2352x1568px · retinal fundus photograph · 45° FOV: 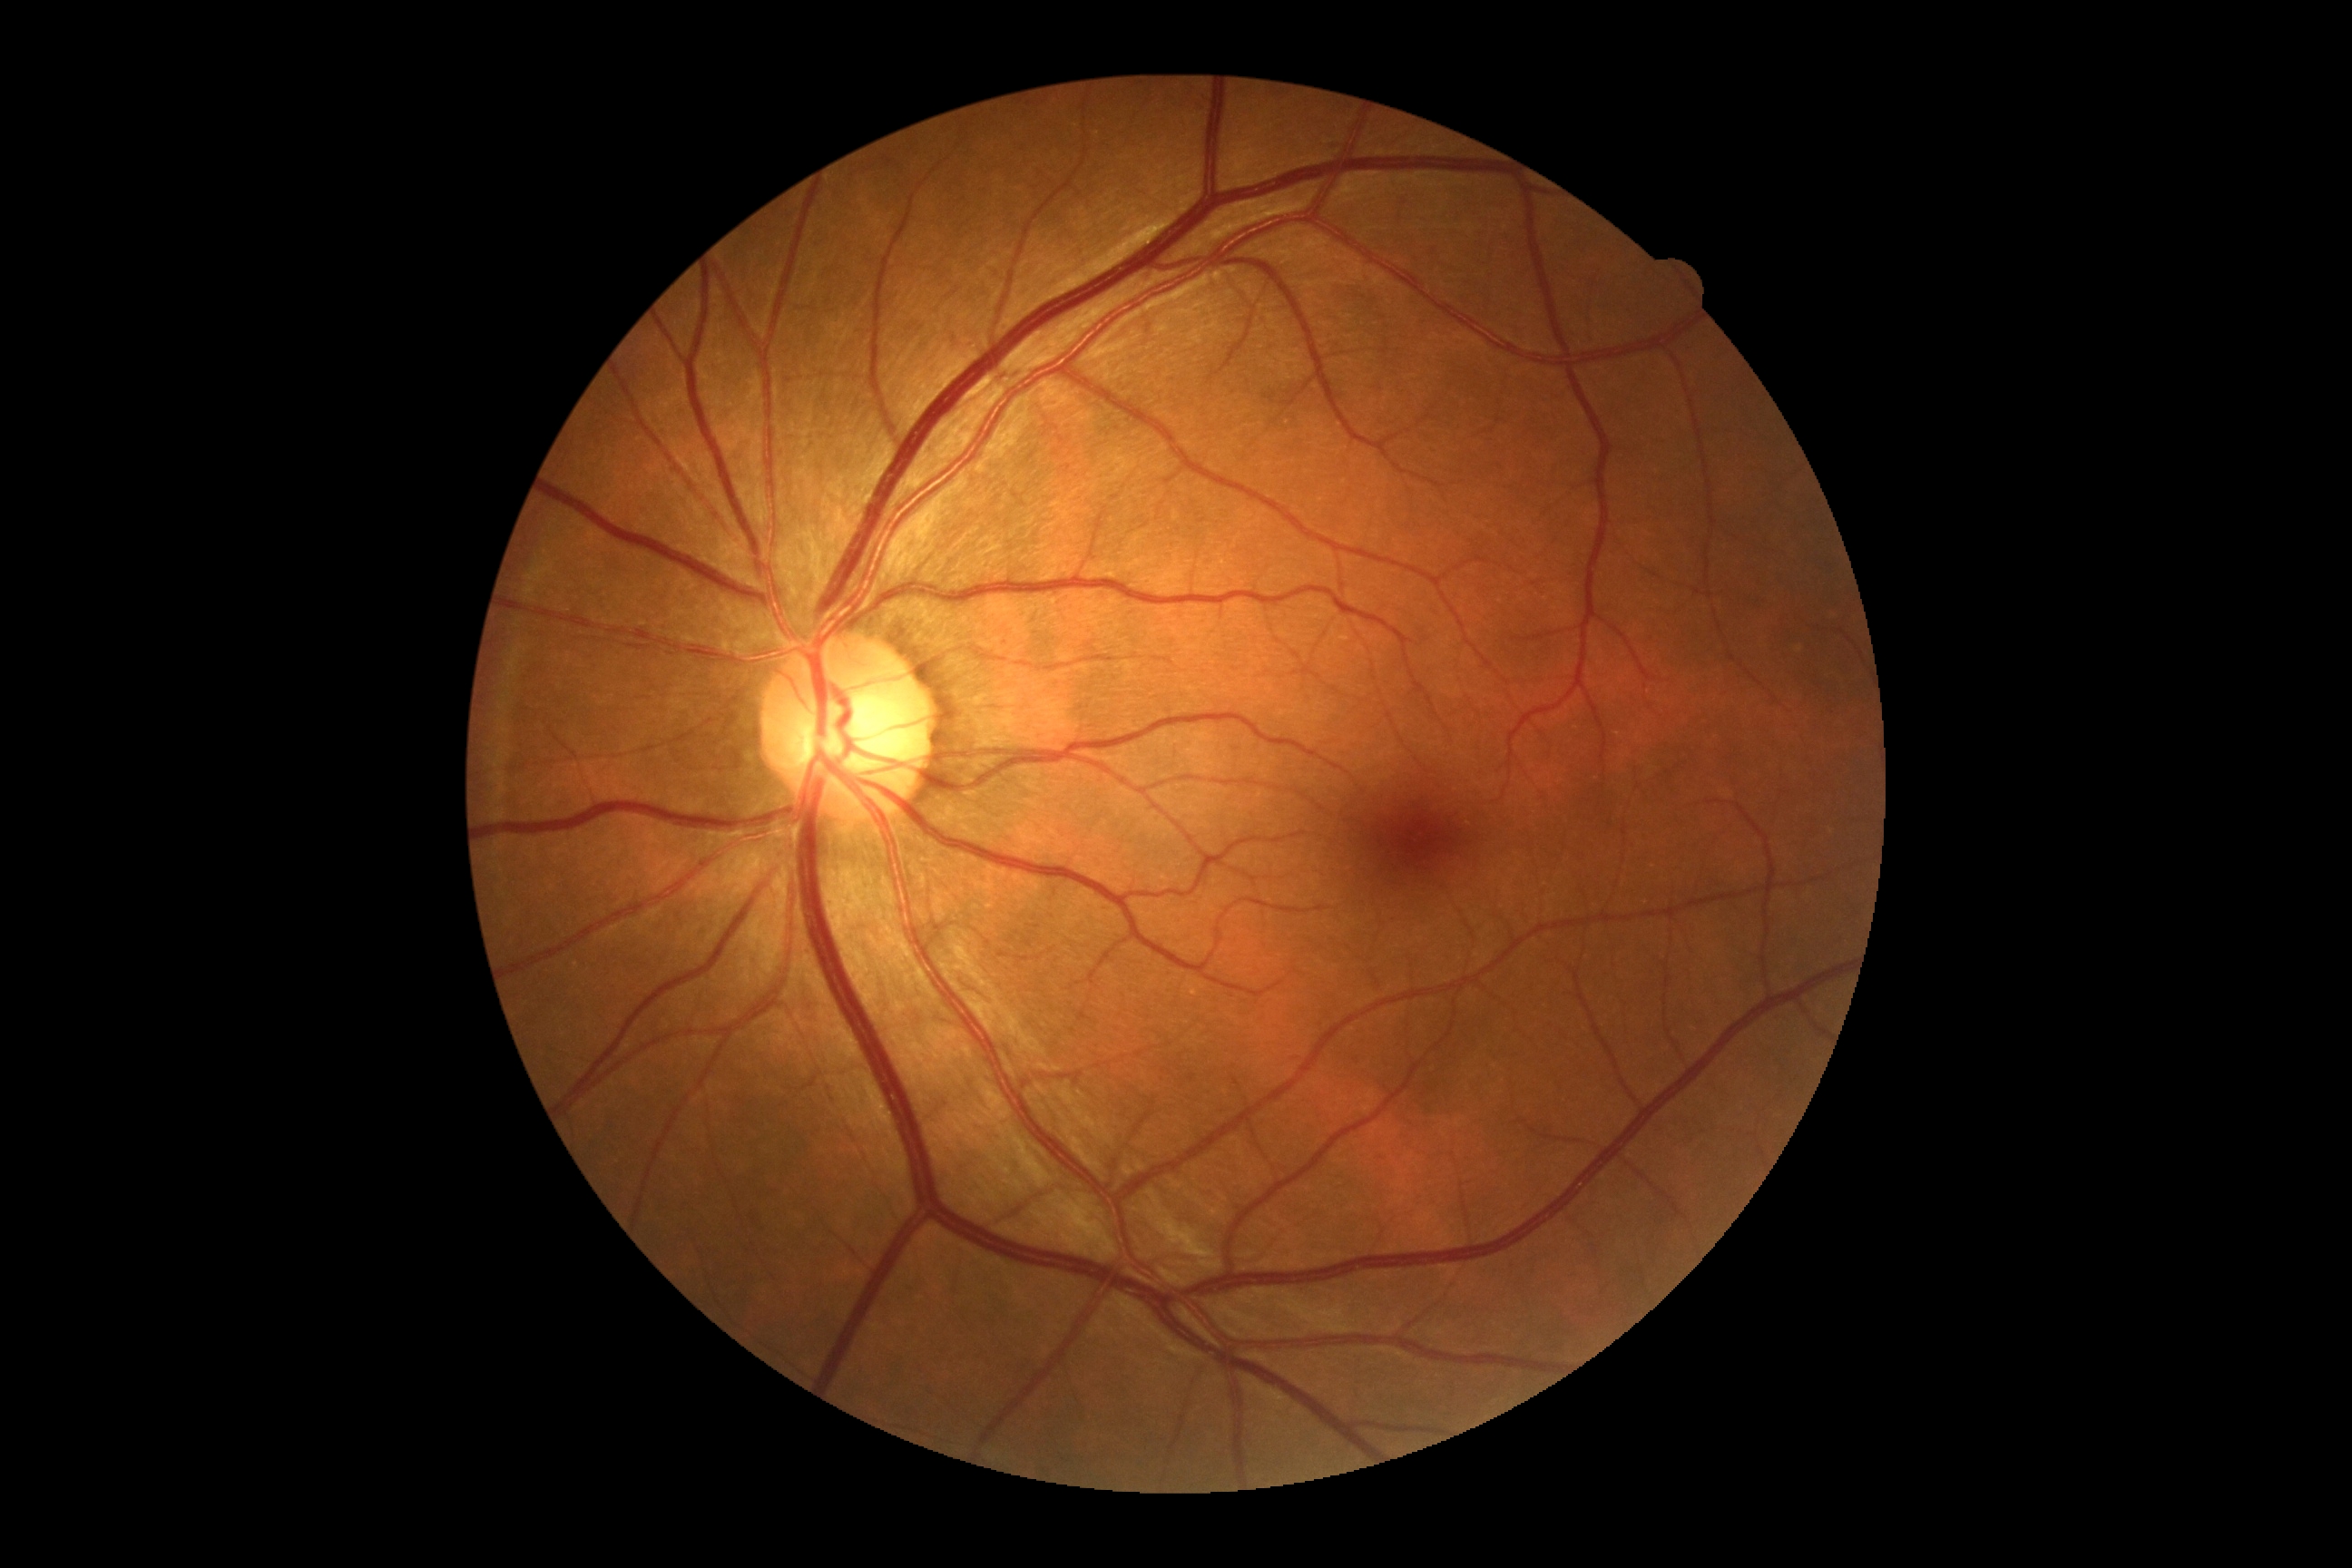 DR severity: no apparent retinopathy (grade 0).